Disc-centered fundus crop · Topcon TRC fundus camera: 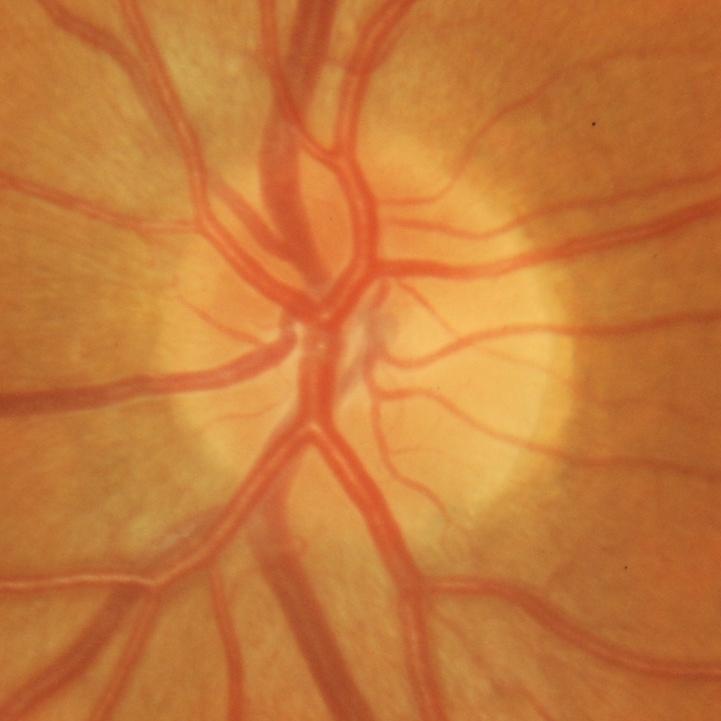
Q: Glaucoma assessment?
A: Yes — glaucomatous optic neuropathy.